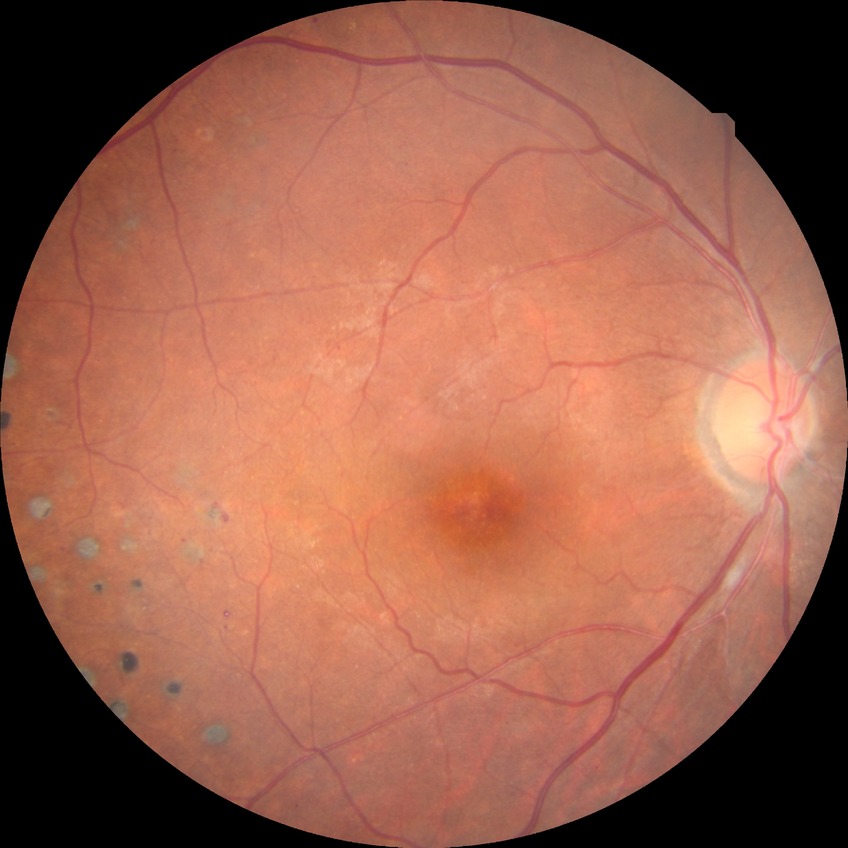 {
  "davis_grade": "proliferative diabetic retinopathy (PDR)"
}